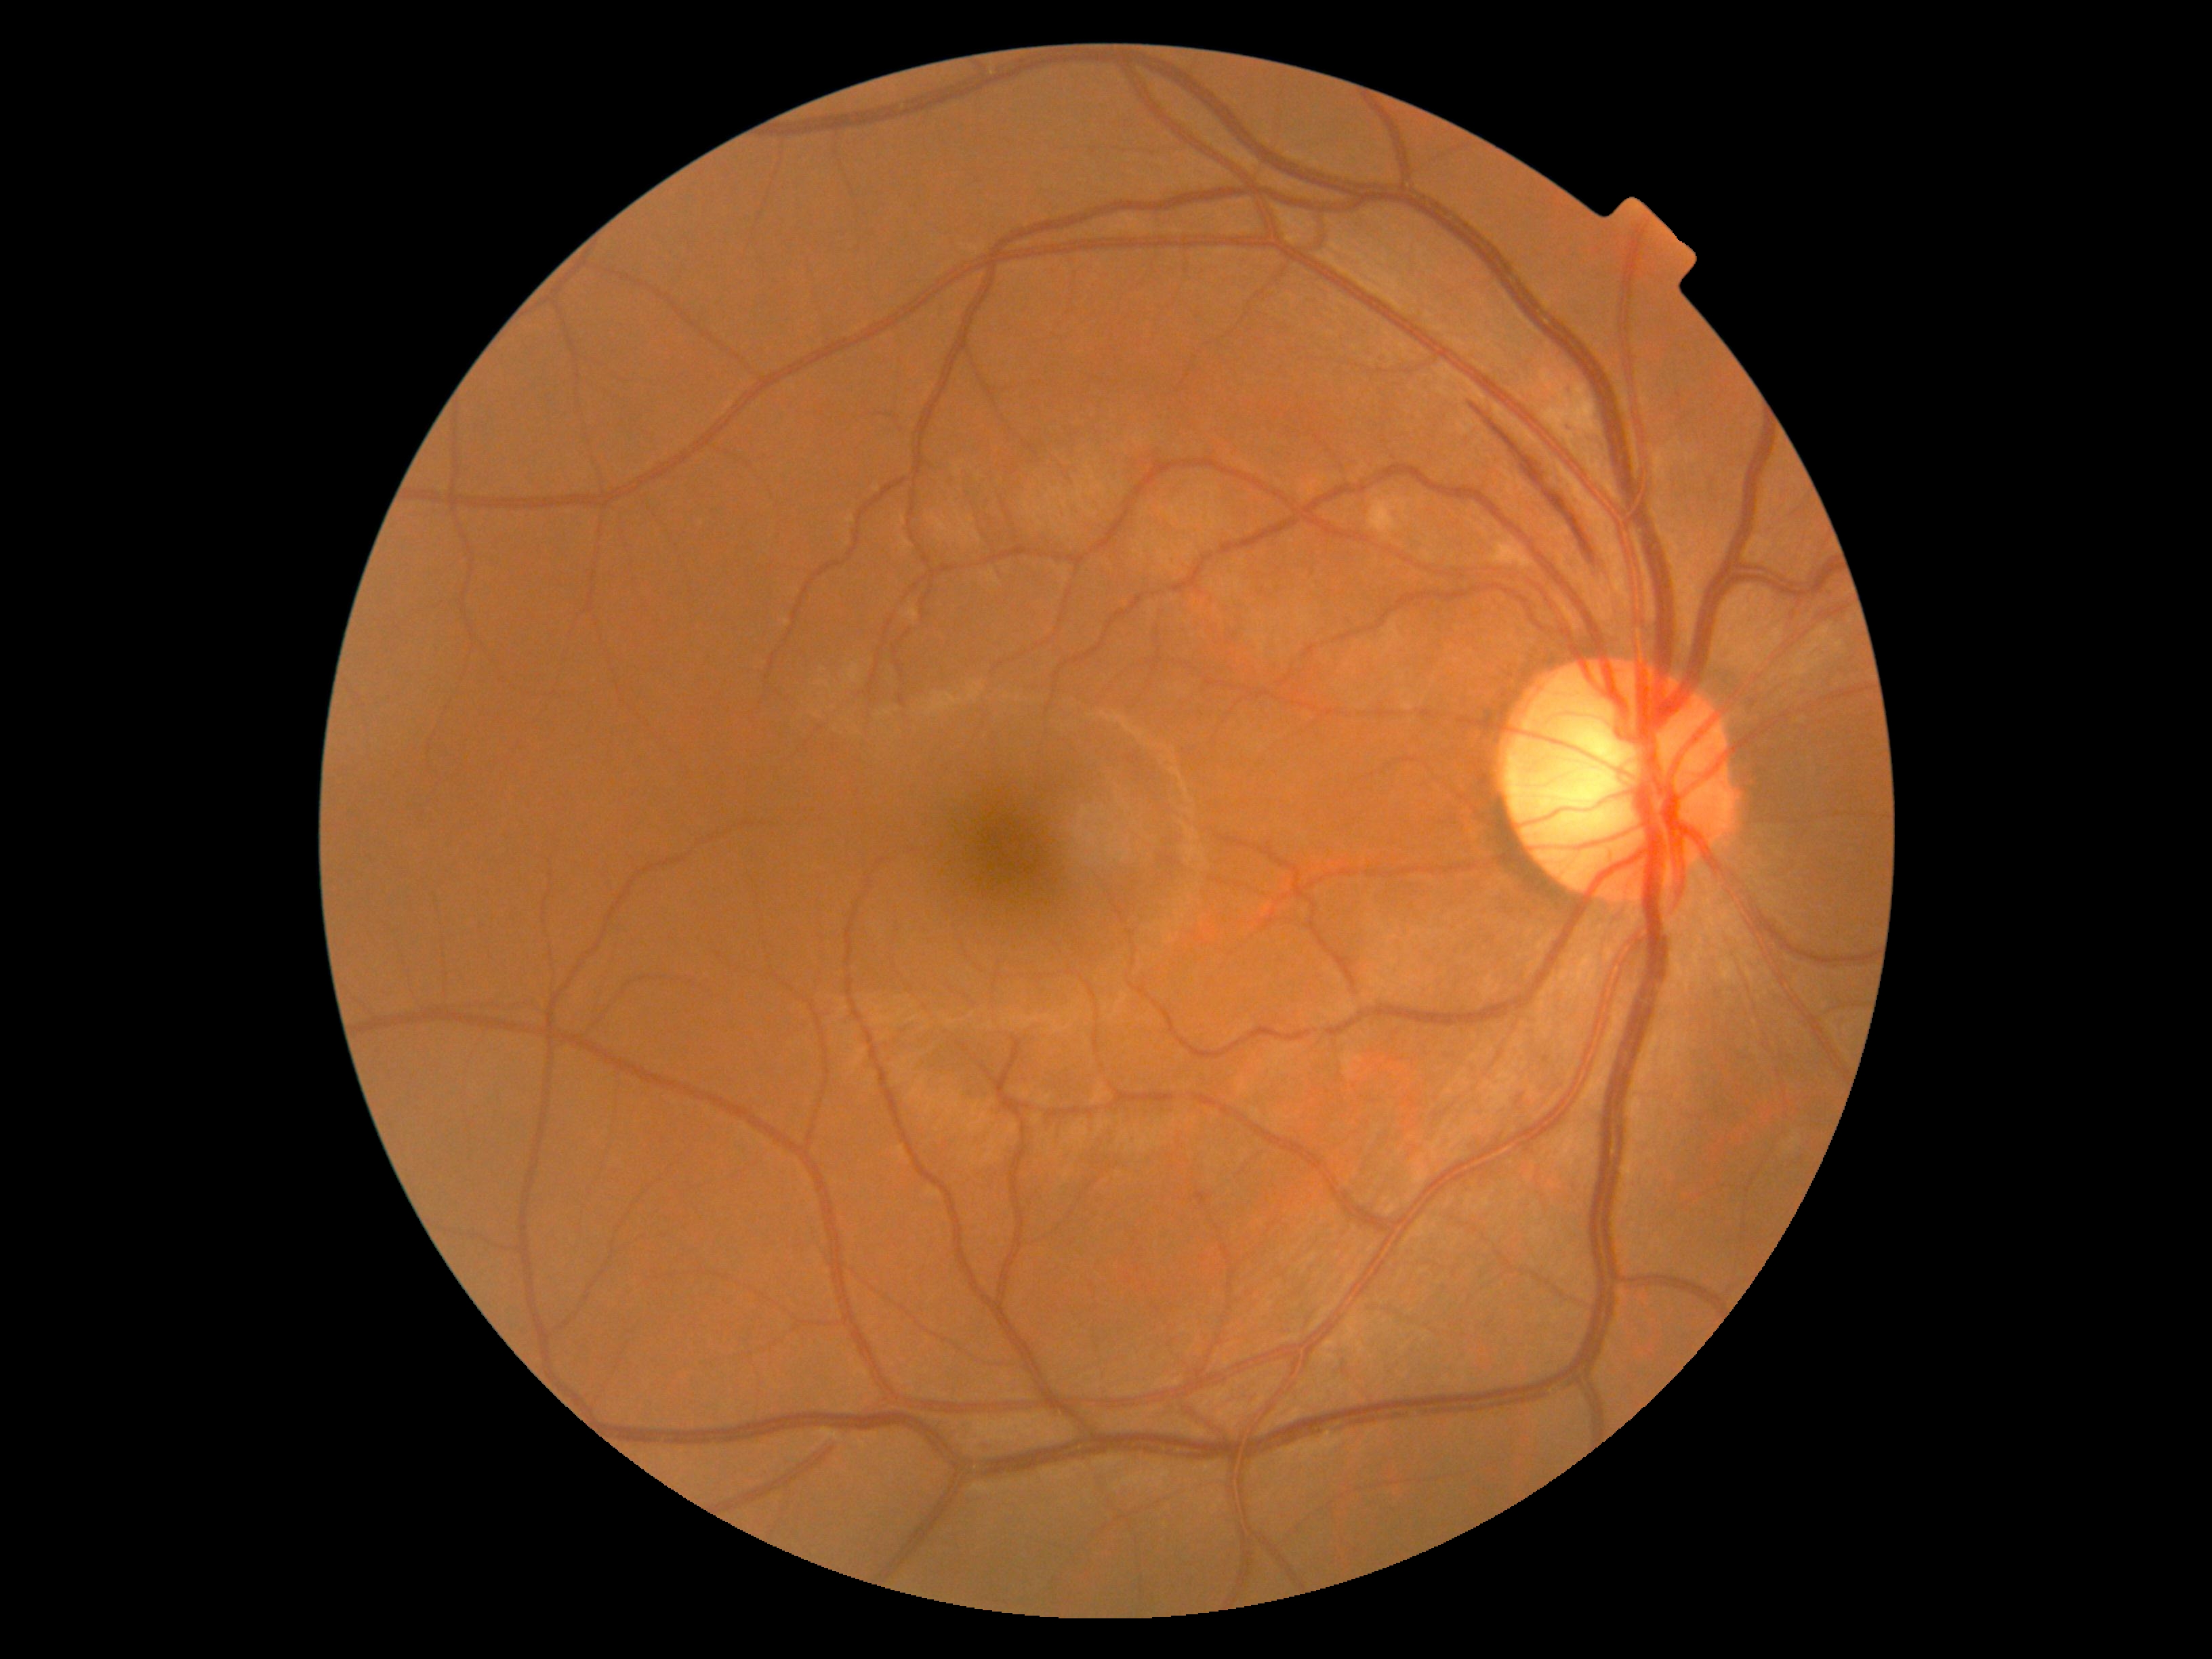 dr_category: non-proliferative diabetic retinopathy
dr_grade: 2/4